50° FOV · color fundus photograph — 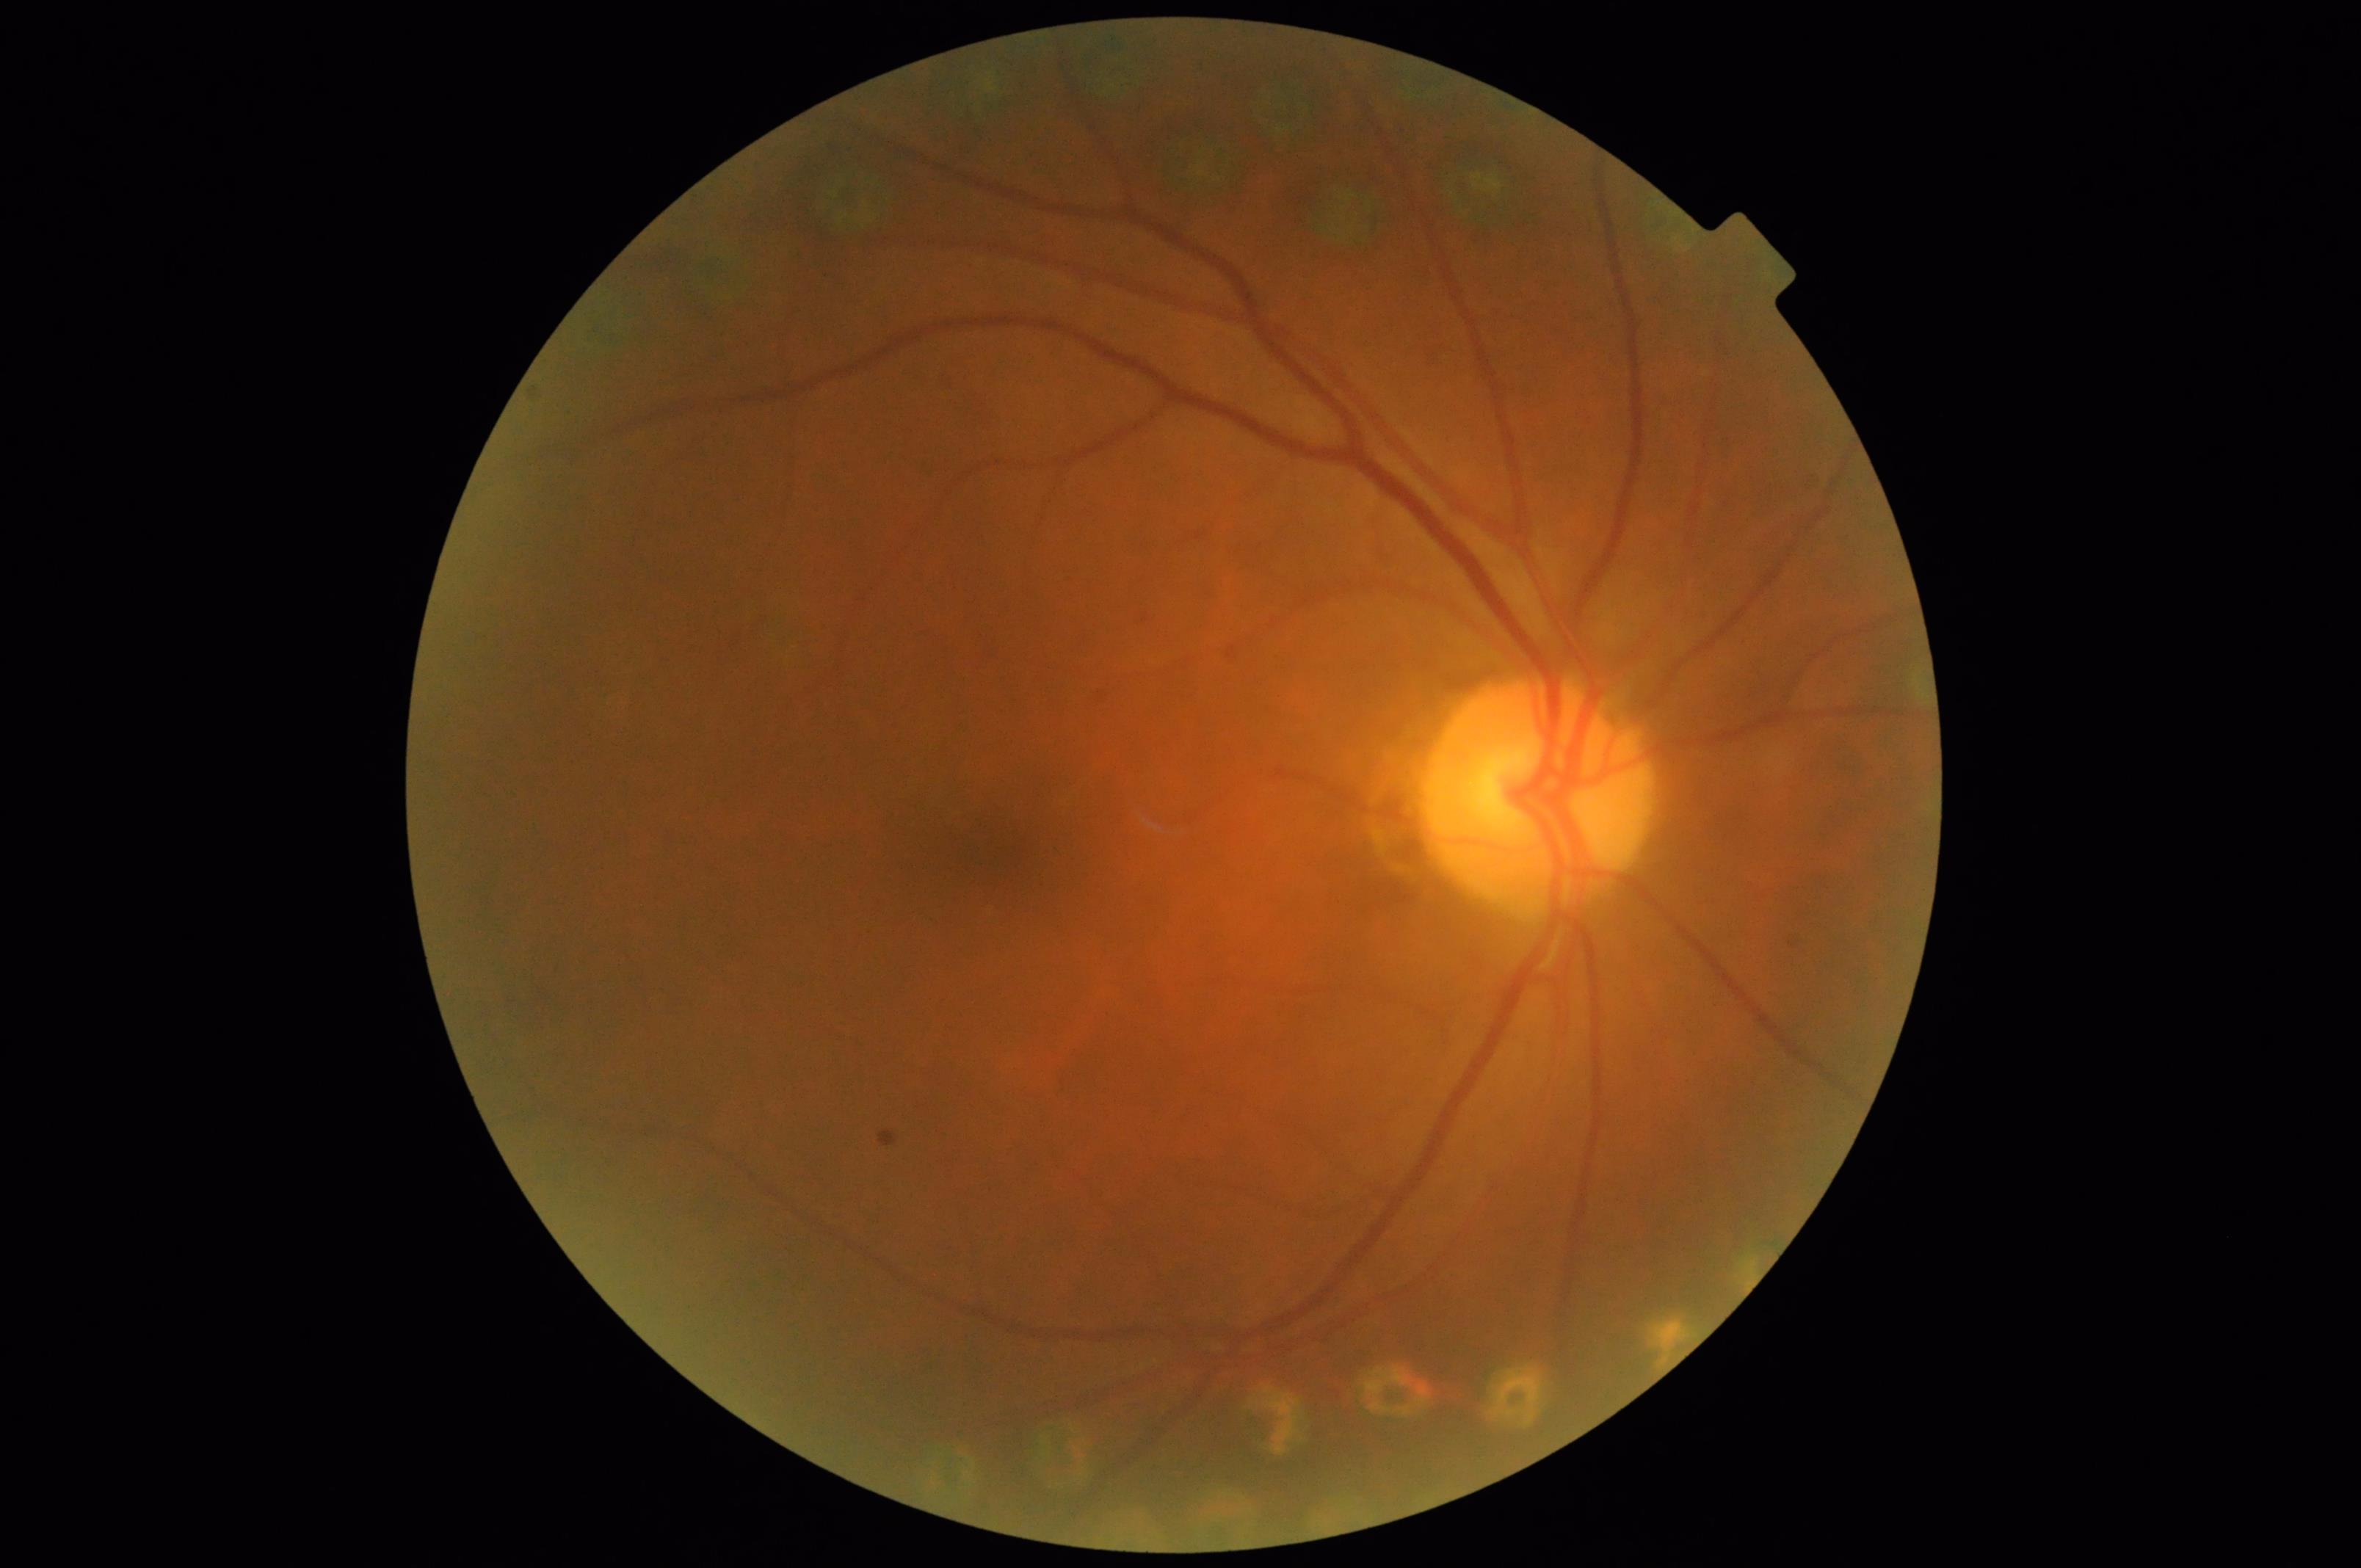

Out of focus; structures are indistinct. Image quality is inadequate for diagnostic use. Vessels and details are readily distinguishable. There is over- or under-exposure or a color cast.